Image size 1932x1932.
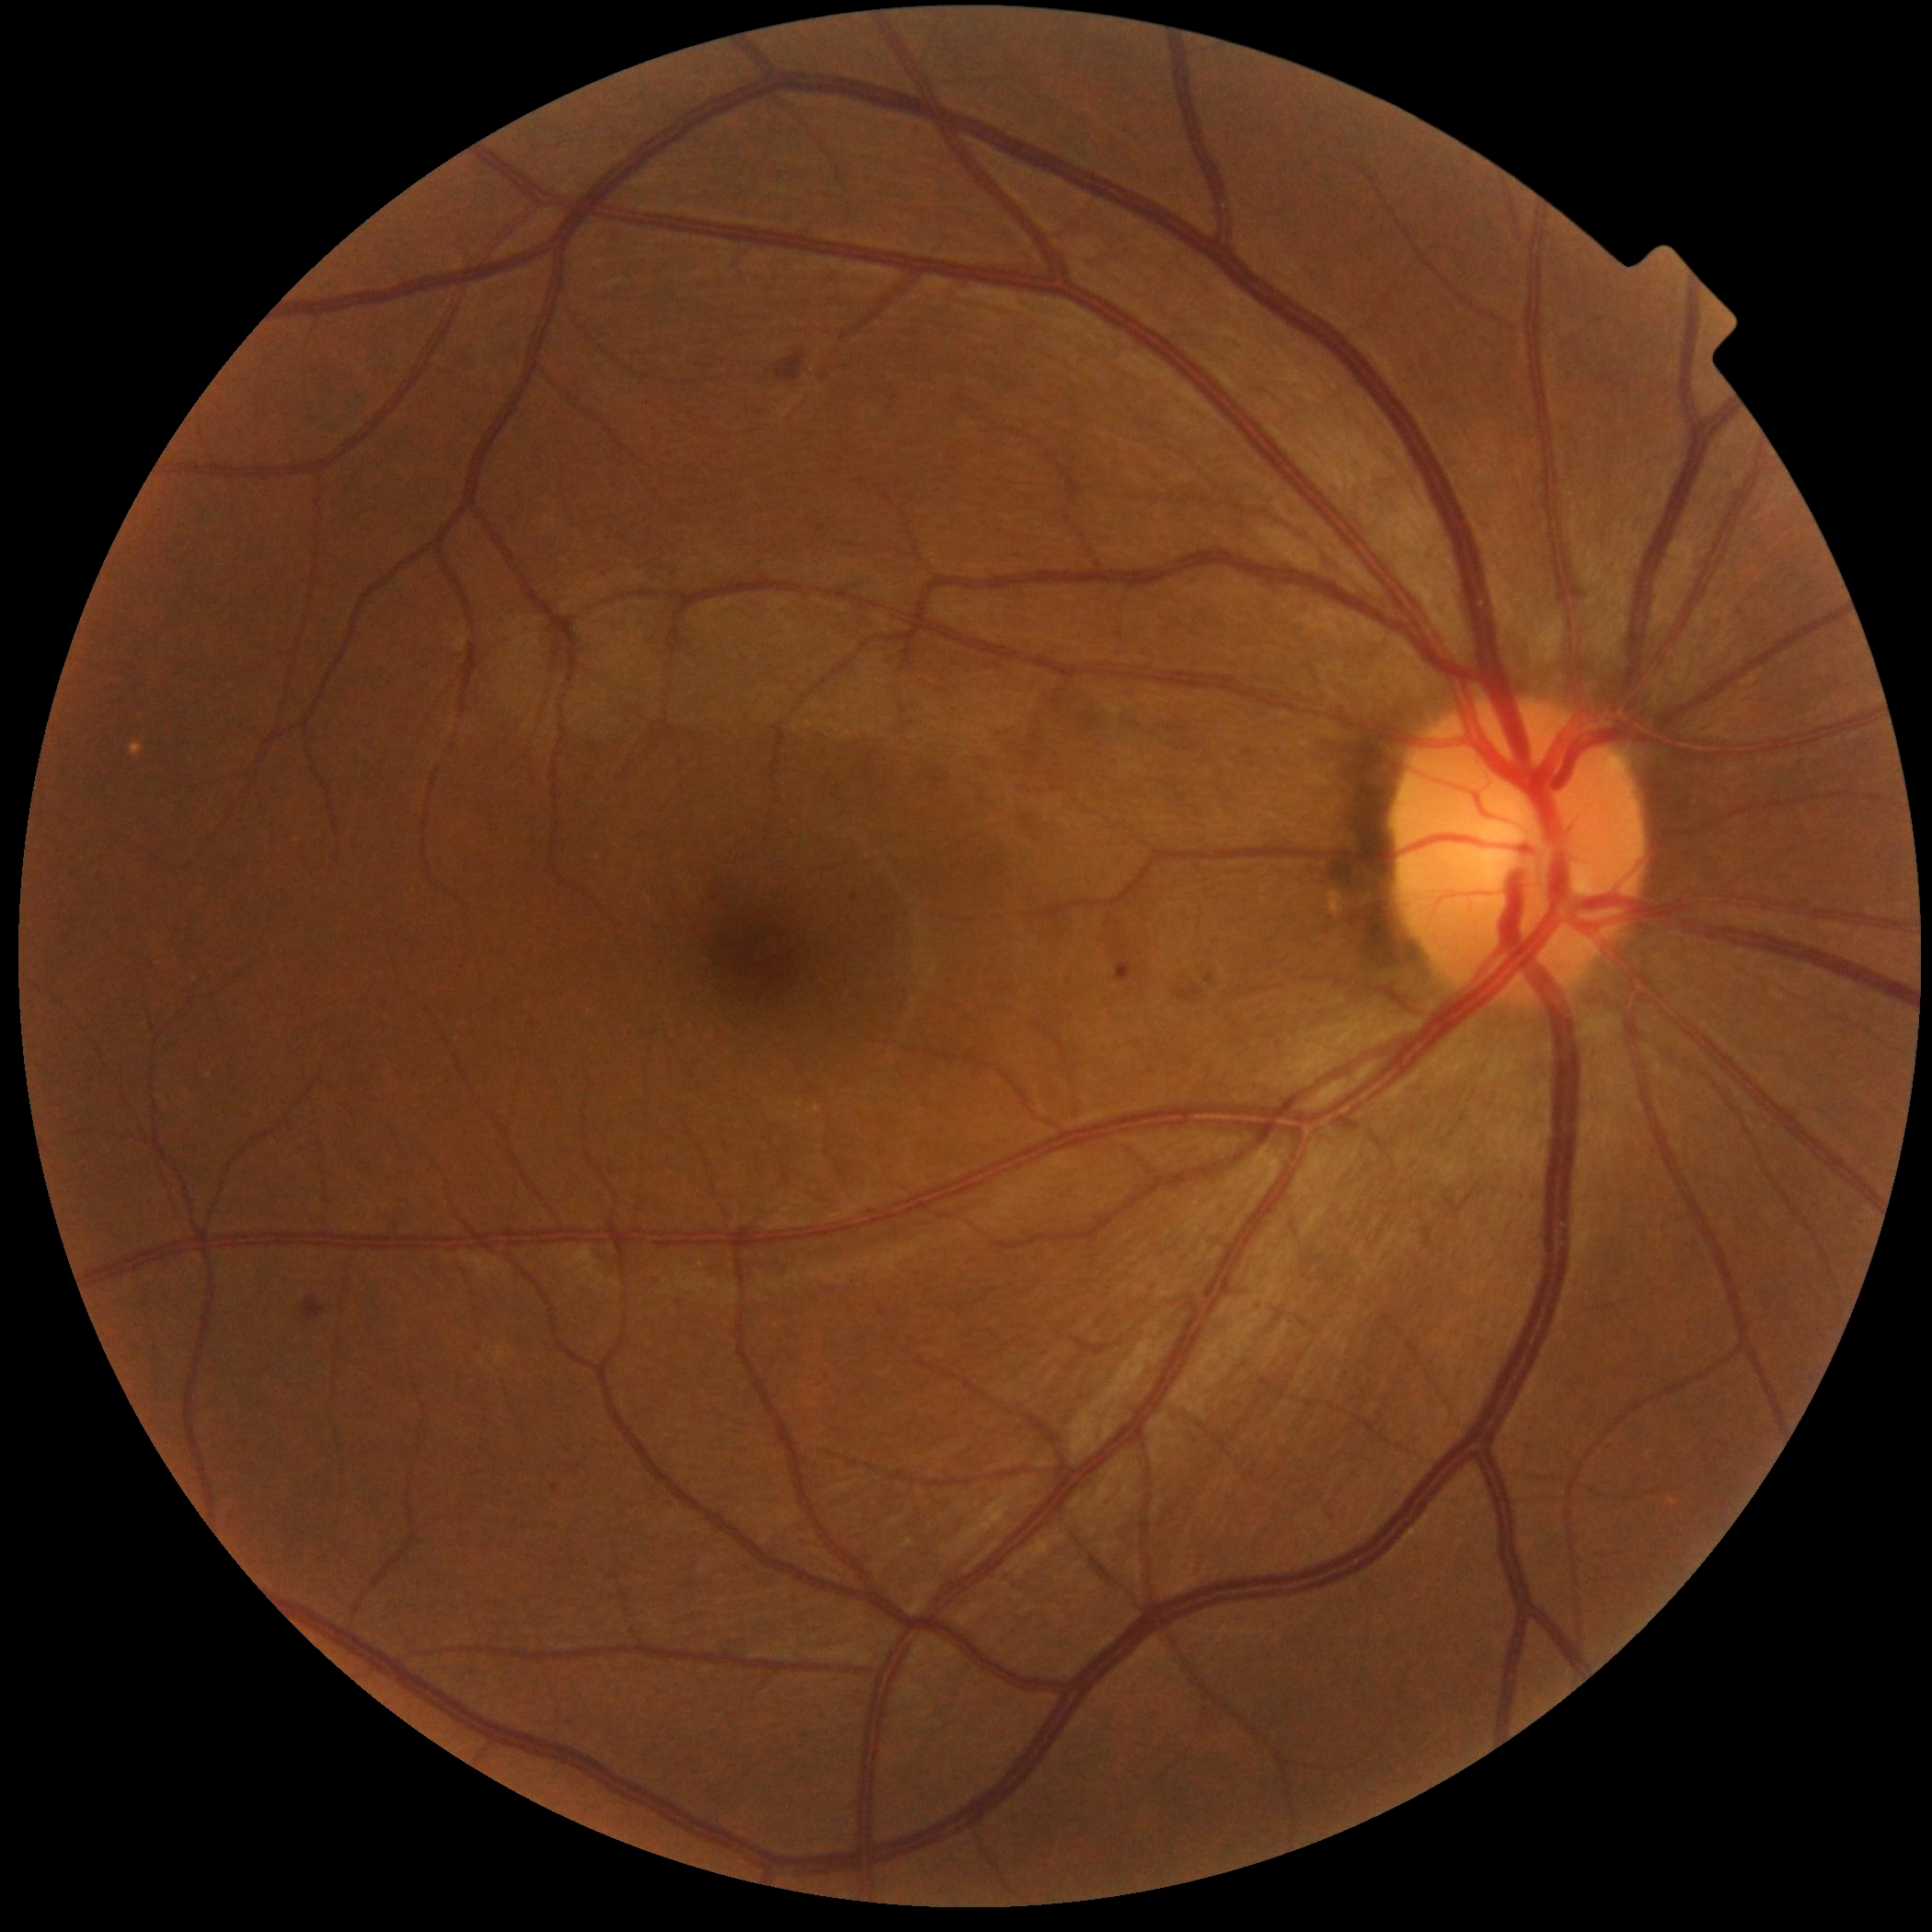

Retinopathy grade: 2 (moderate NPDR).